DR severity per modified Davis staging; FOV: 45 degrees; 848x848
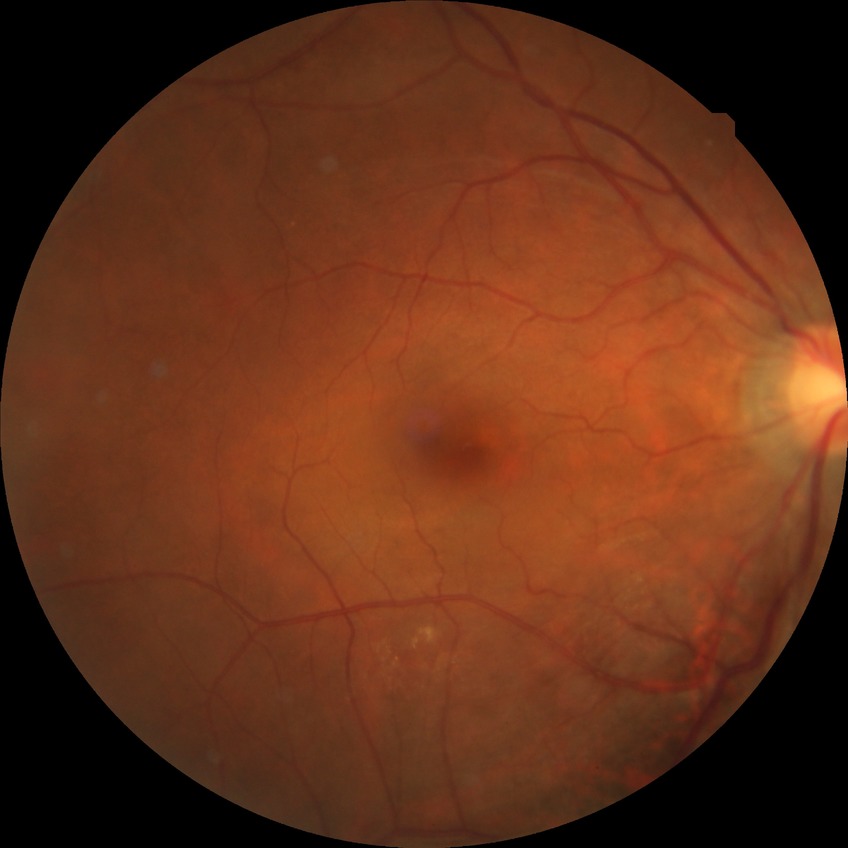 Retinopathy grade: no diabetic retinopathy.